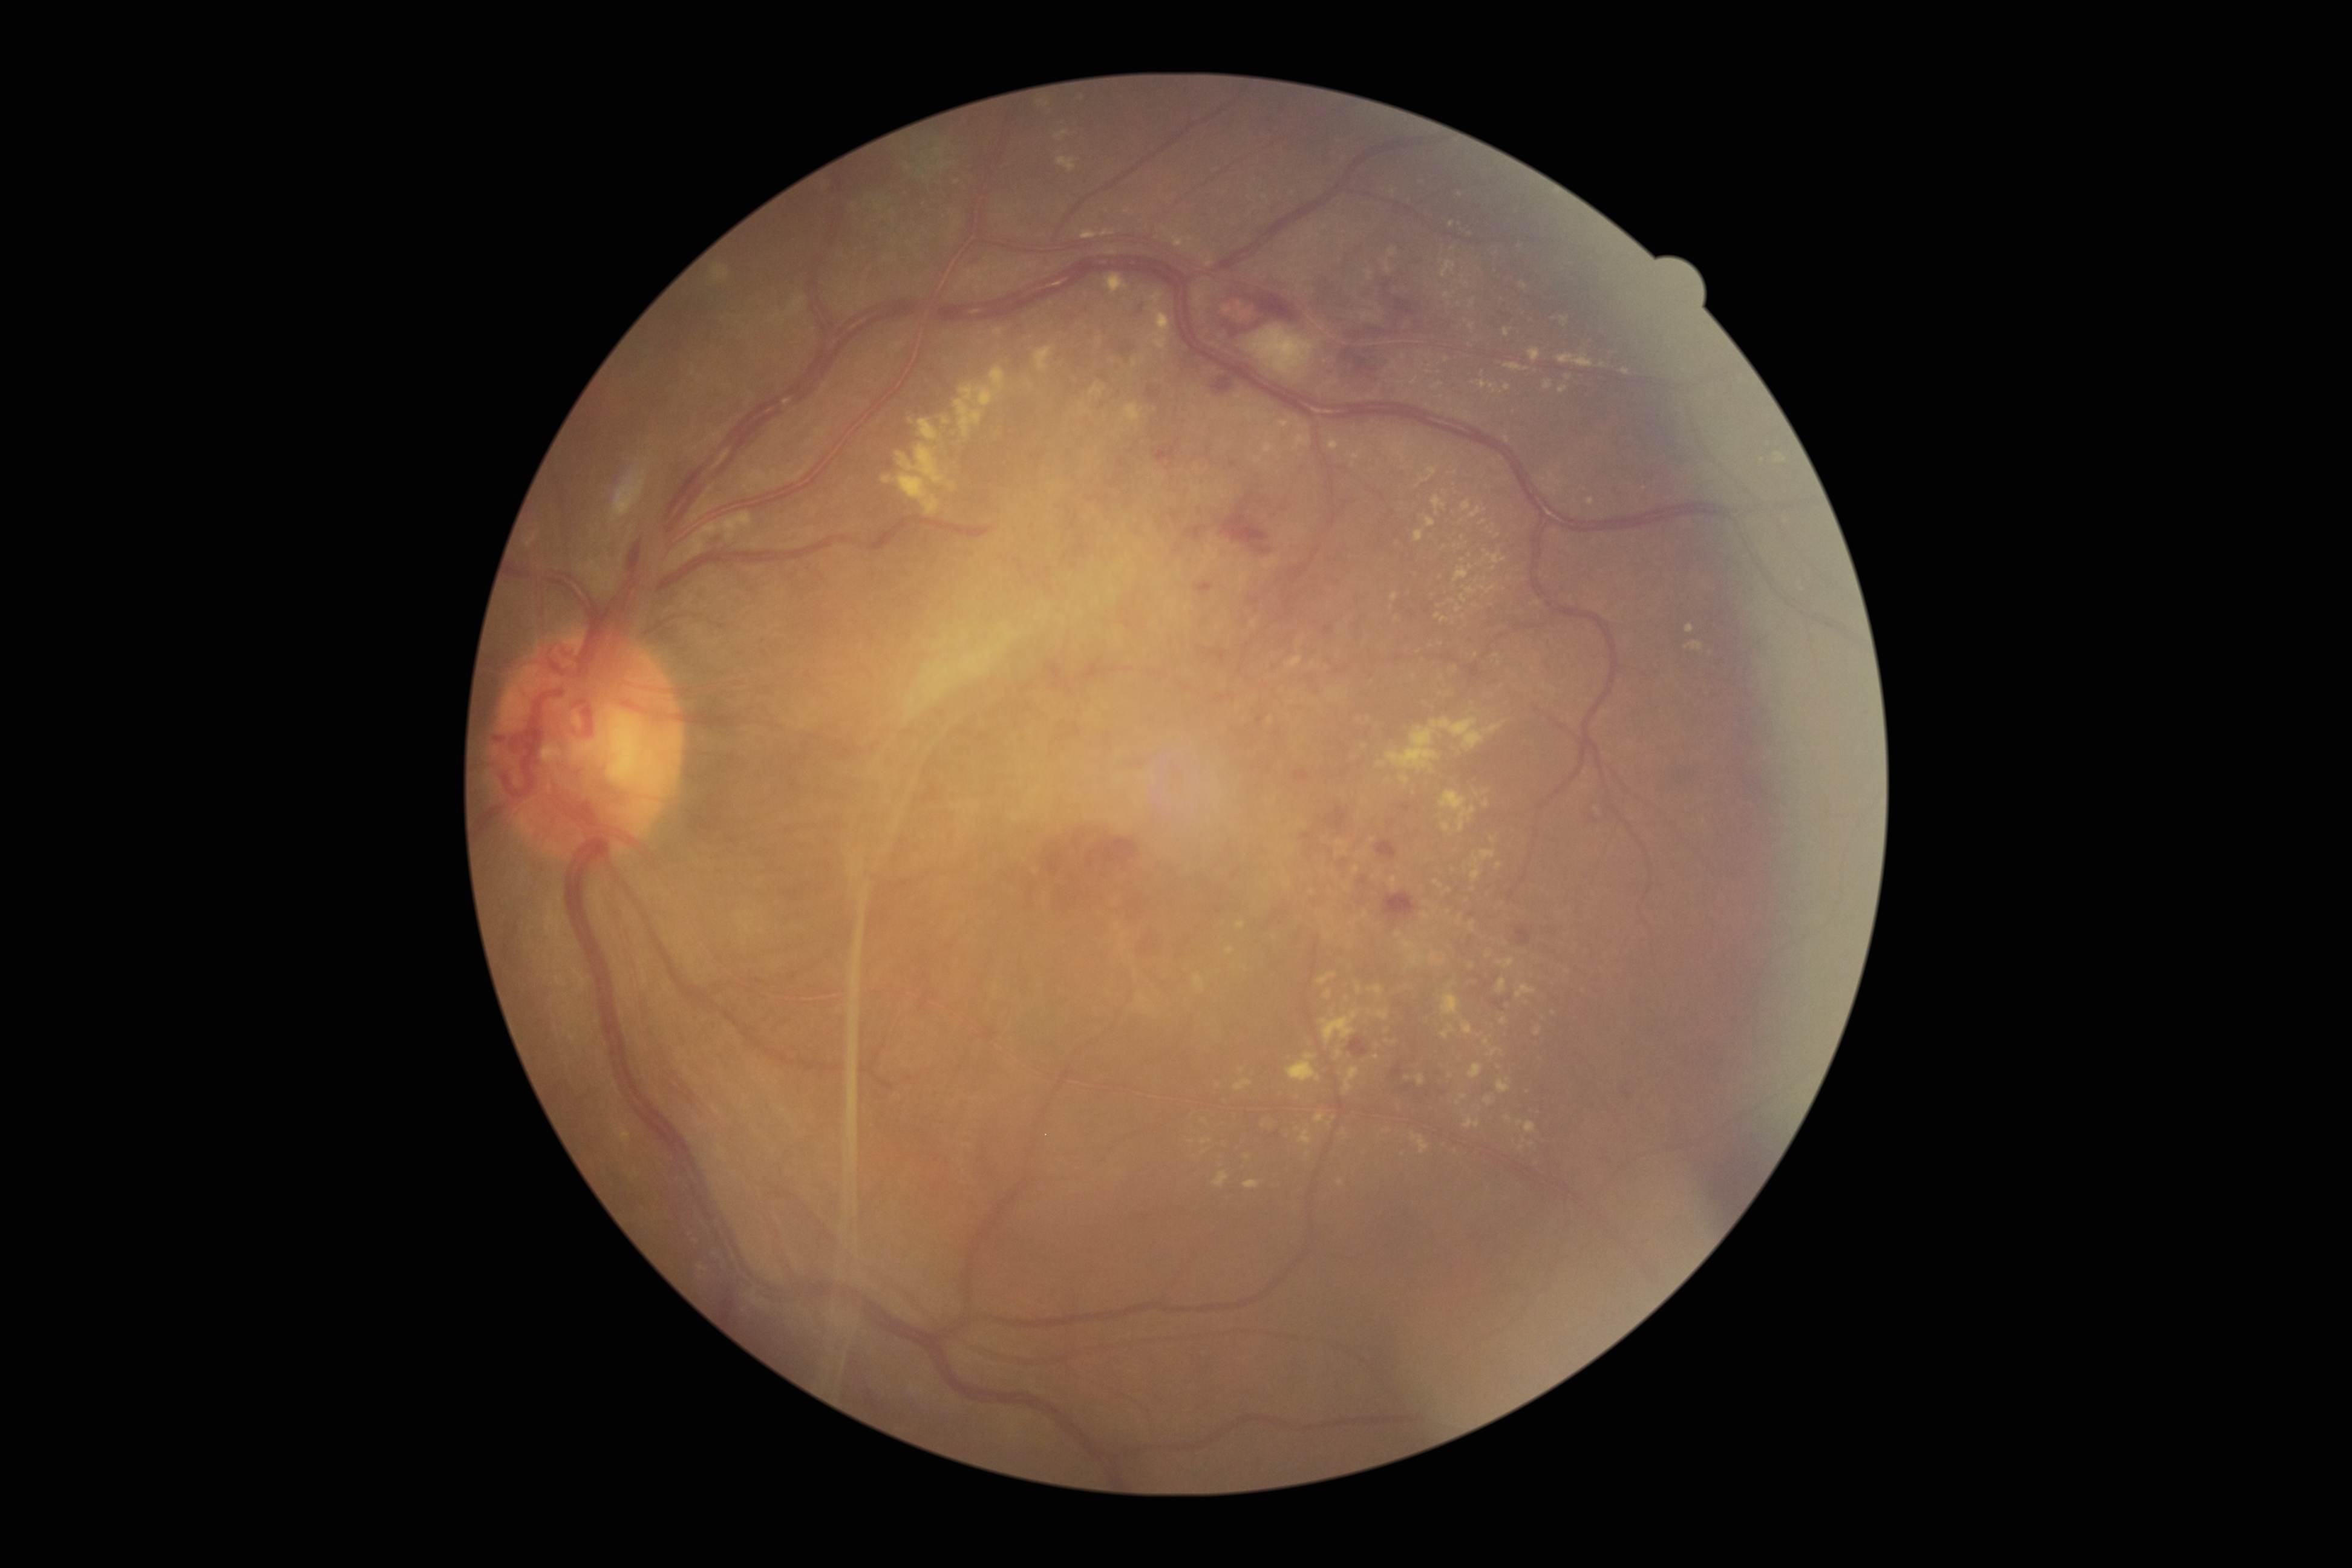 DR: 4/4. EXs include lesions at (1480,520,1488,526) | (697,1265,707,1271) | (1335,1048,1344,1060) | (1471,850,1496,881) | (1174,240,1184,247) | (1483,720,1507,736) | (1469,298,1475,307) | (1285,656,1302,668) | (1414,529,1423,543) | (1559,385,1567,395) | (1362,313,1381,321) | (1154,315,1169,330). EXs (small, approximate centers) near [x=1493, y=840] | [x=1372, y=840] | [x=1532, y=1144] | [x=1429, y=372] | [x=957, y=183] | [x=1469, y=345] | [x=1347, y=888] | [x=1313, y=664].